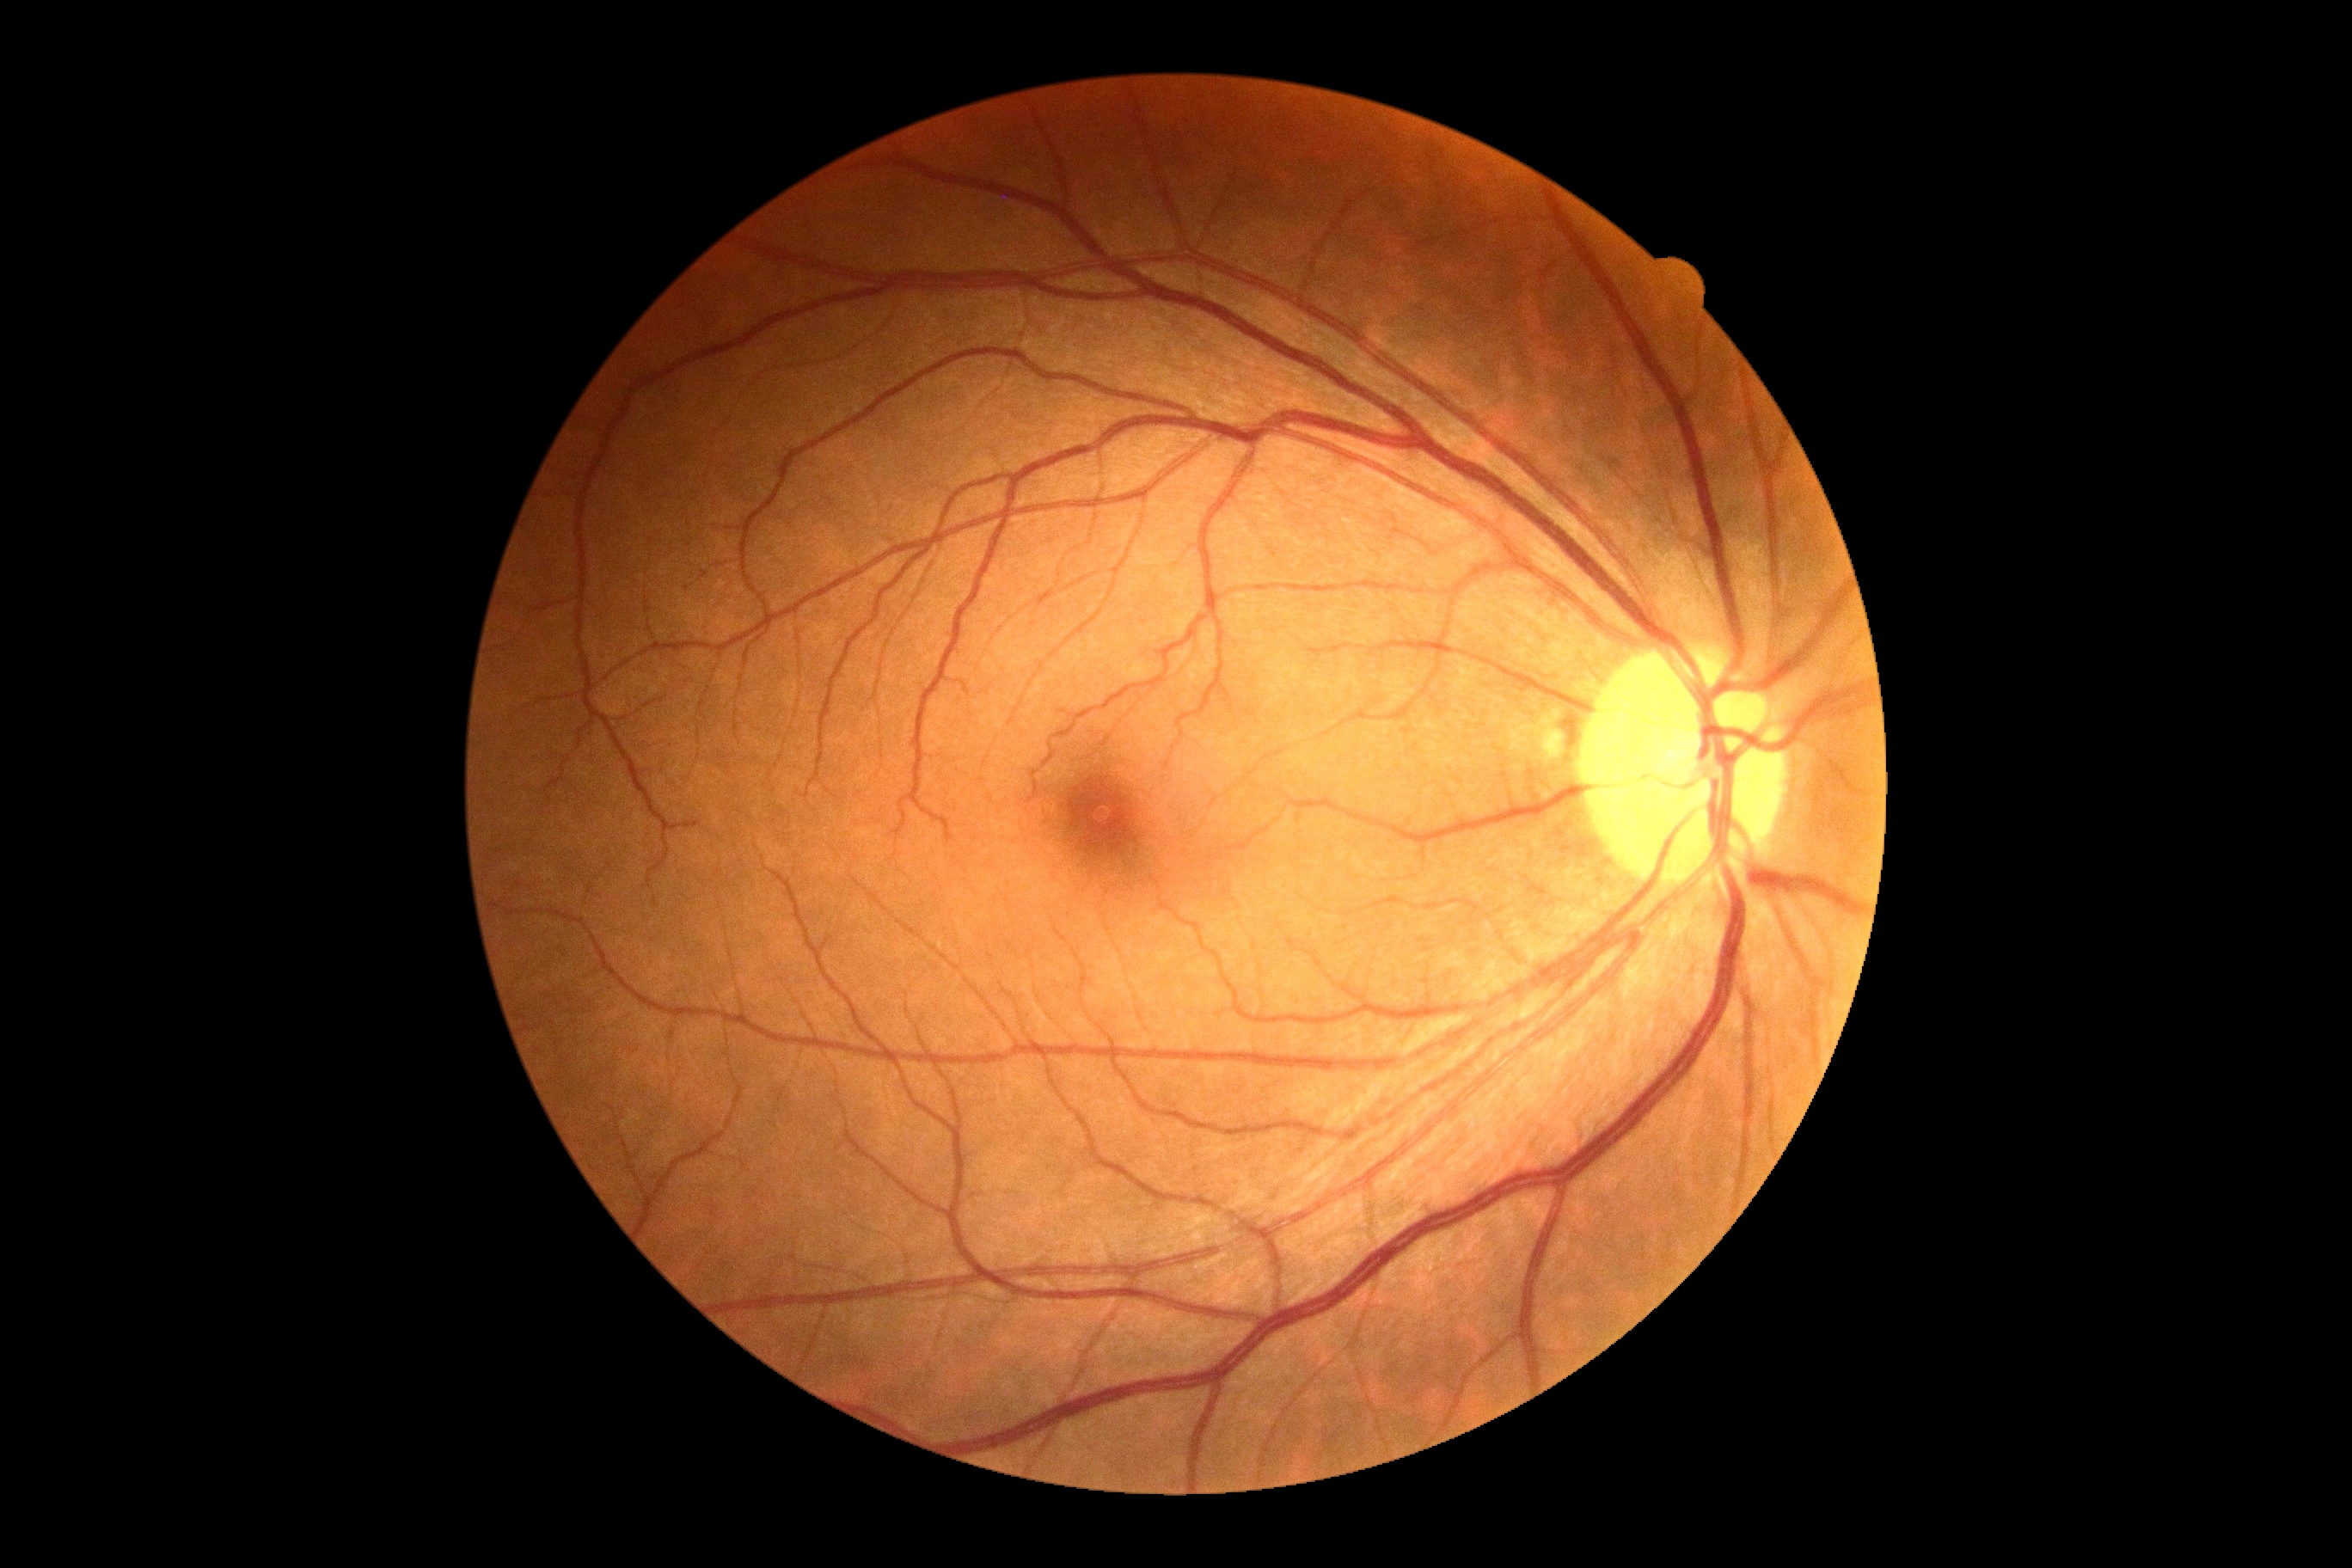 Diabetic retinopathy (DR) is no apparent retinopathy (grade 0) — no visible signs of diabetic retinopathy.